Fundus photo
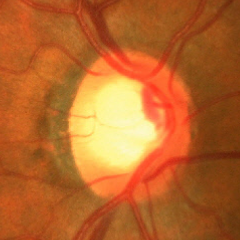
Assessment: advanced glaucoma.